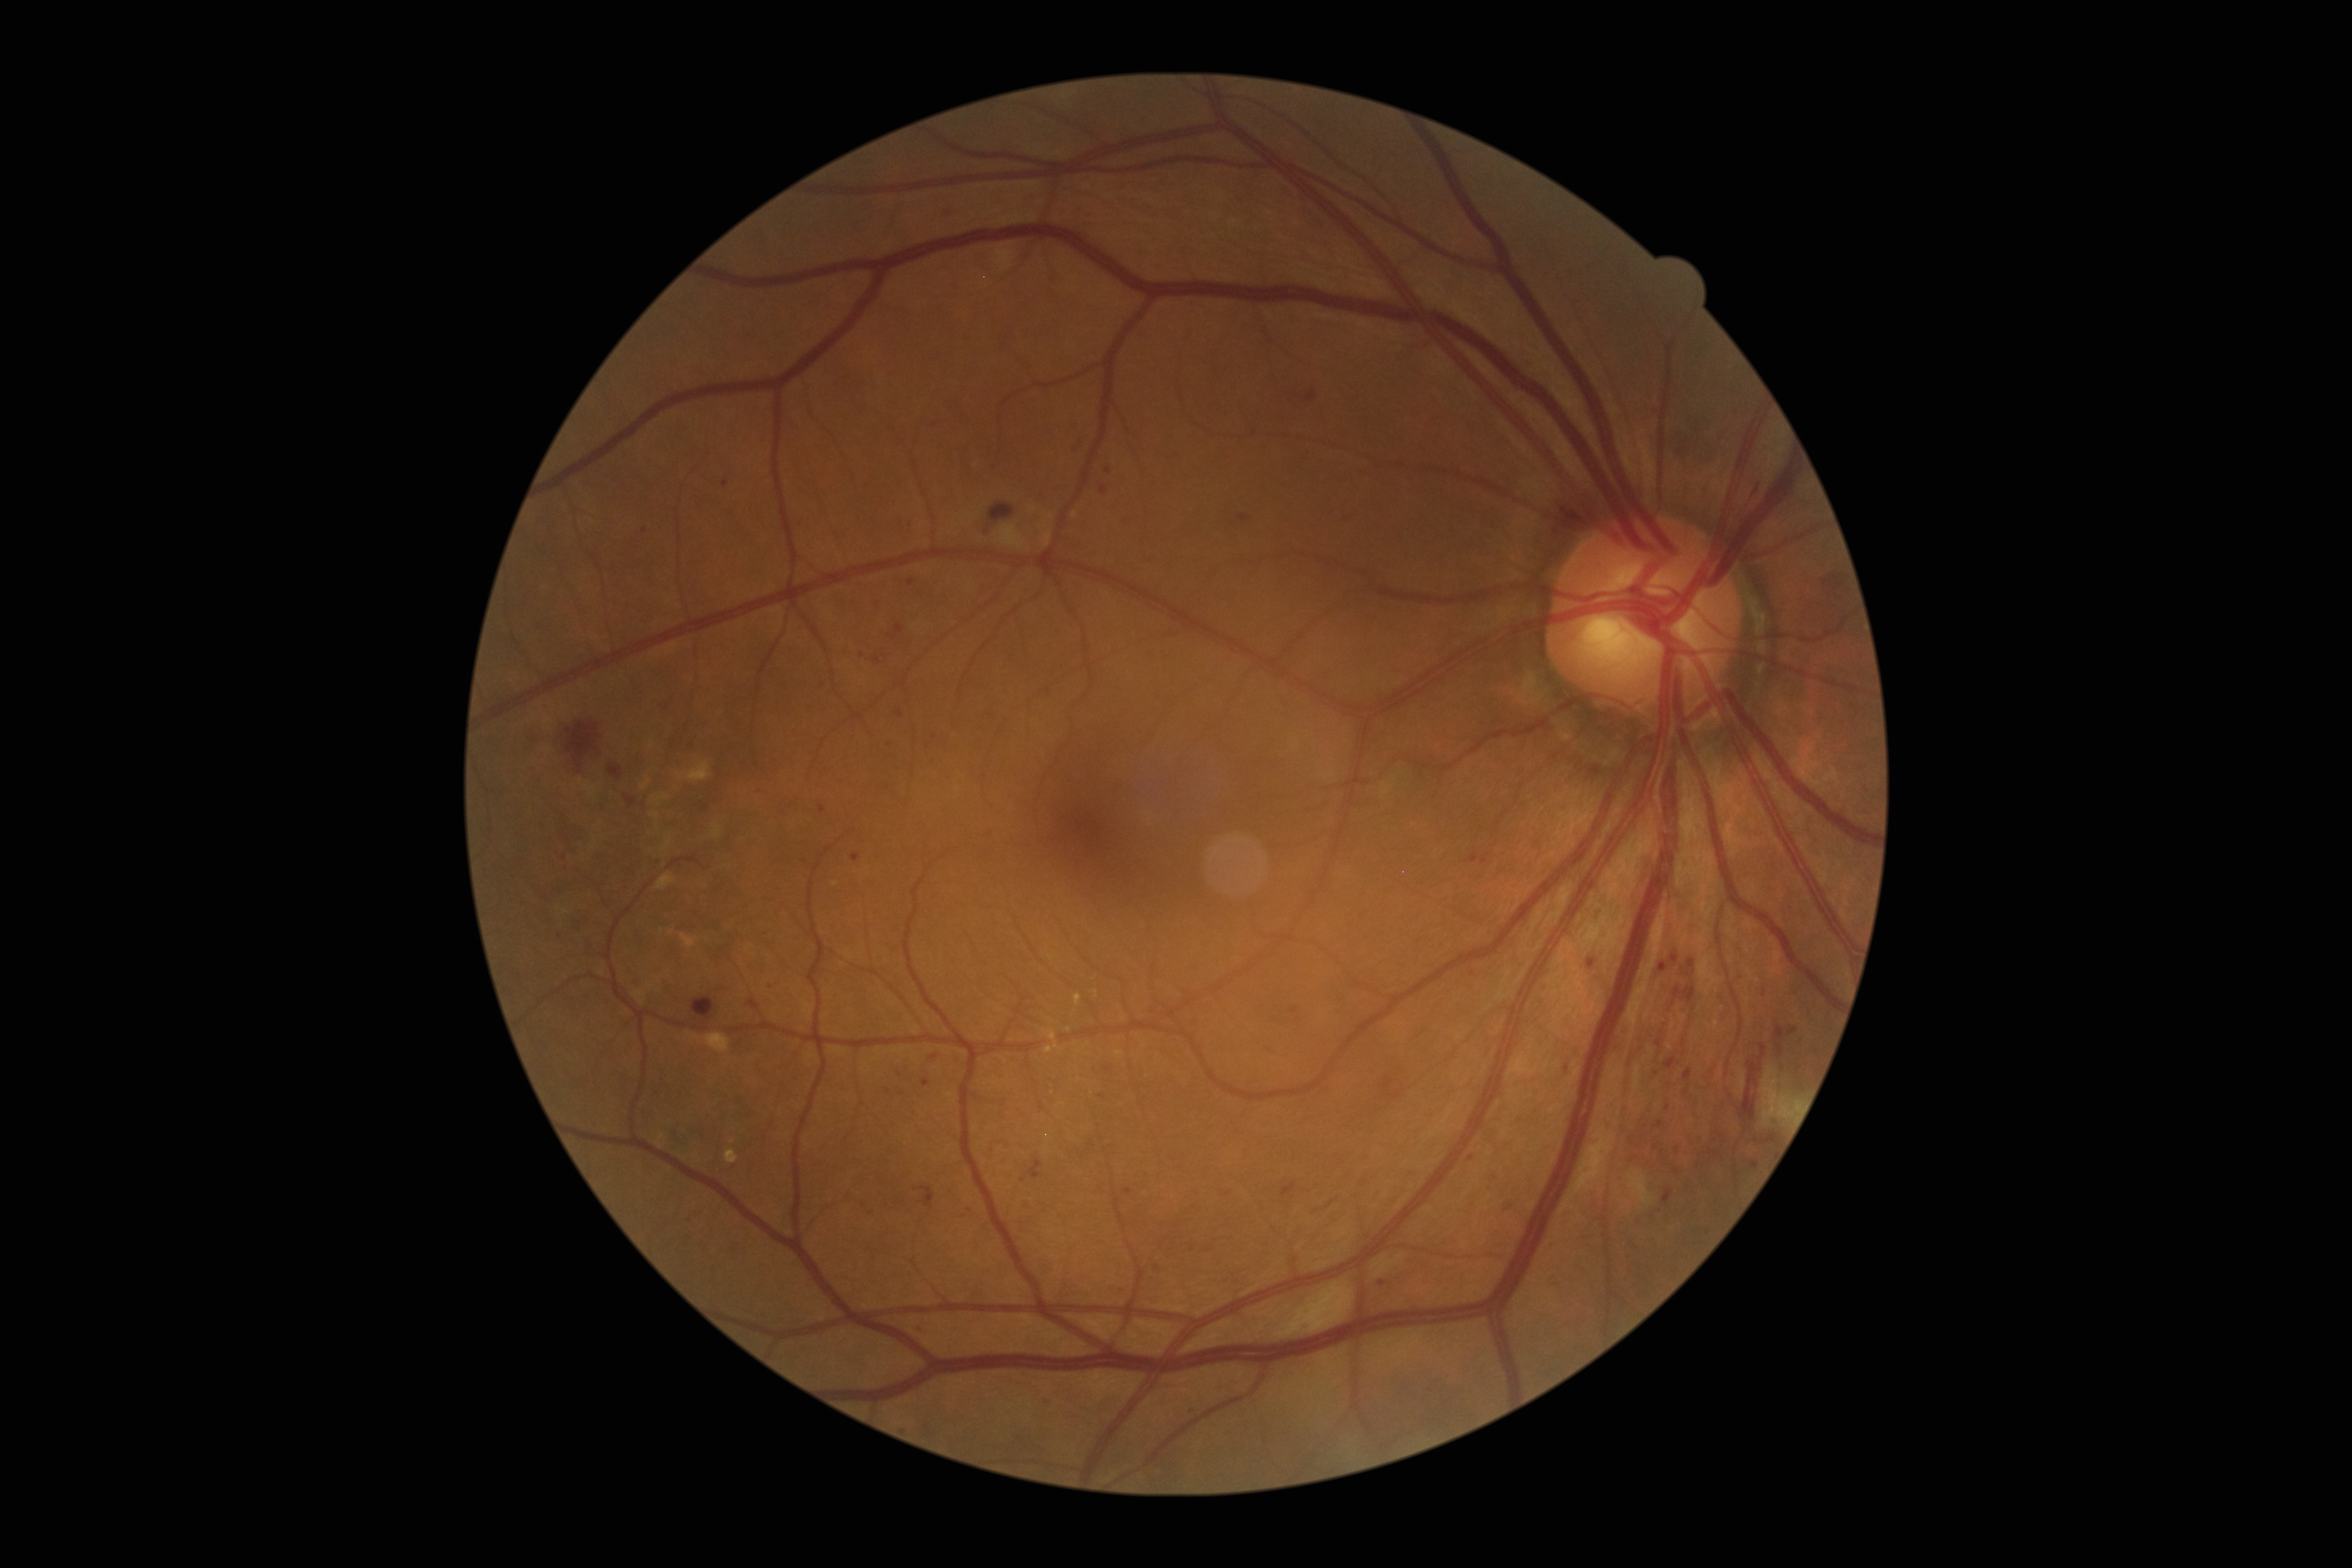

DR stage is moderate NPDR (grade 2).
MAs include [895,625,904,632]; [1042,1400,1051,1409]; [1596,909,1605,924]; [1751,1162,1760,1168]; [1751,477,1762,500]; [983,526,995,534]; [1682,1037,1687,1046]; [946,205,958,217]; [907,521,915,528].
Small MAs near 1157:1267; 1382:1282; 1295:1010; 658:864; 1192:1411; 873:1215; 771:989; 1108:471; 1077:427.